Disc-centered fundus crop, image size 961x961, 35° FOV before cropping — 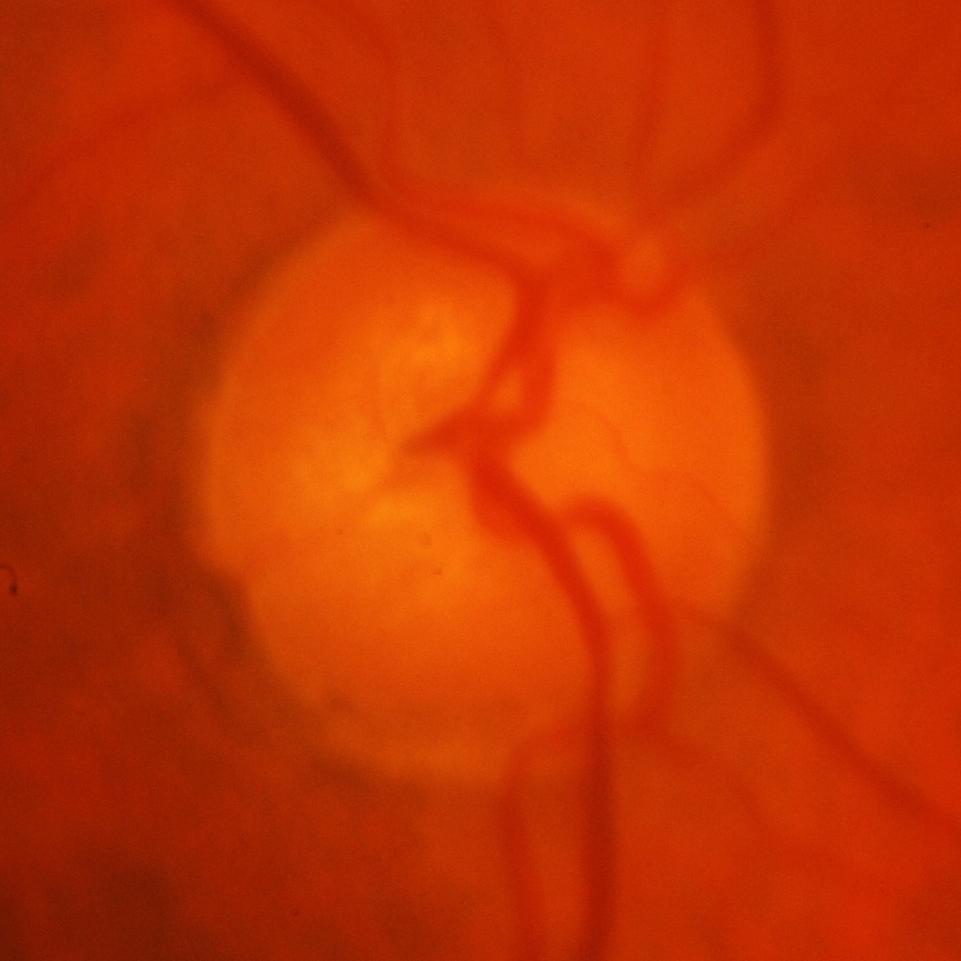 Showing glaucomatous findings.